848 by 848 pixels. No pharmacologic dilation: 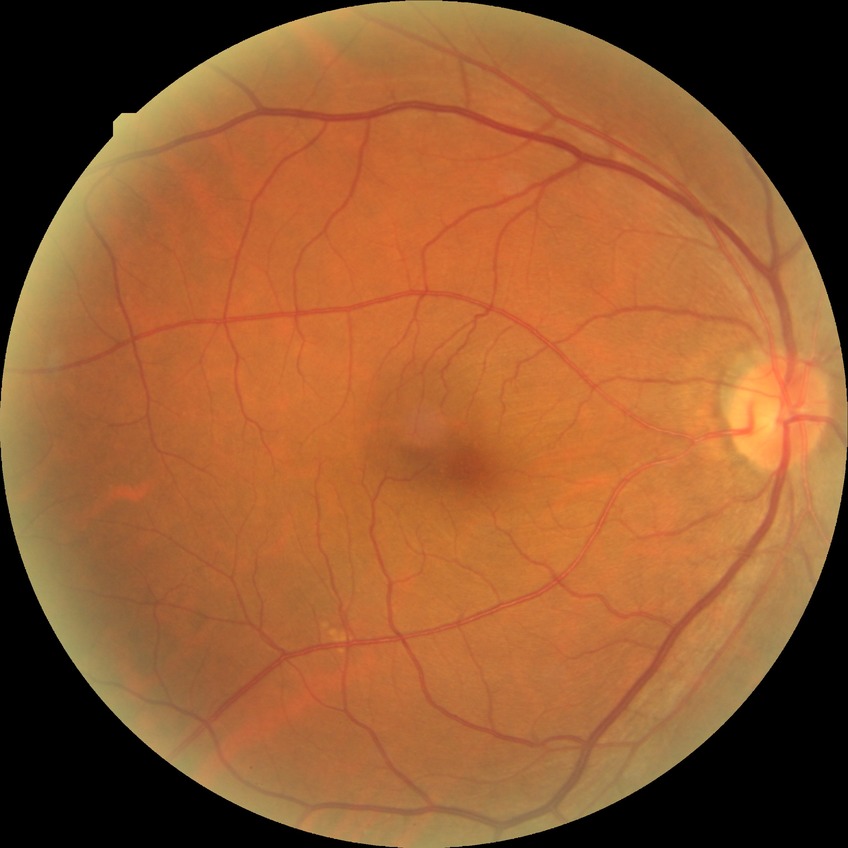
Diabetic retinopathy (DR): NDR (no diabetic retinopathy).